Wide-field fundus photograph from neonatal ROP screening.
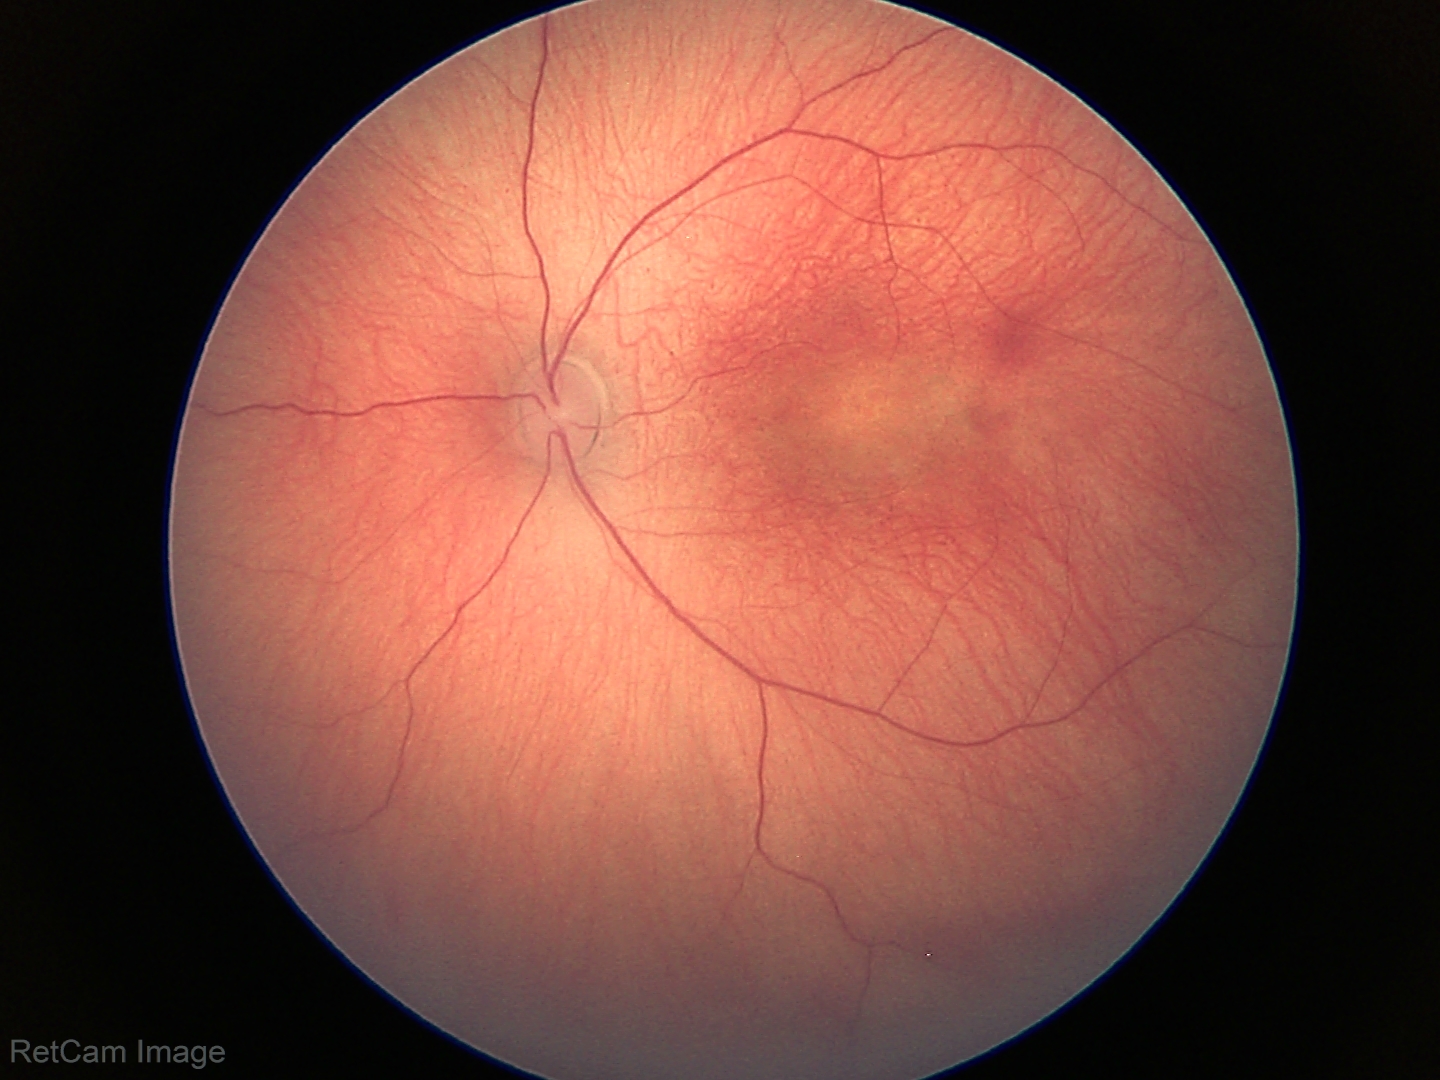 Plus disease = absent | finding = status post ROP.